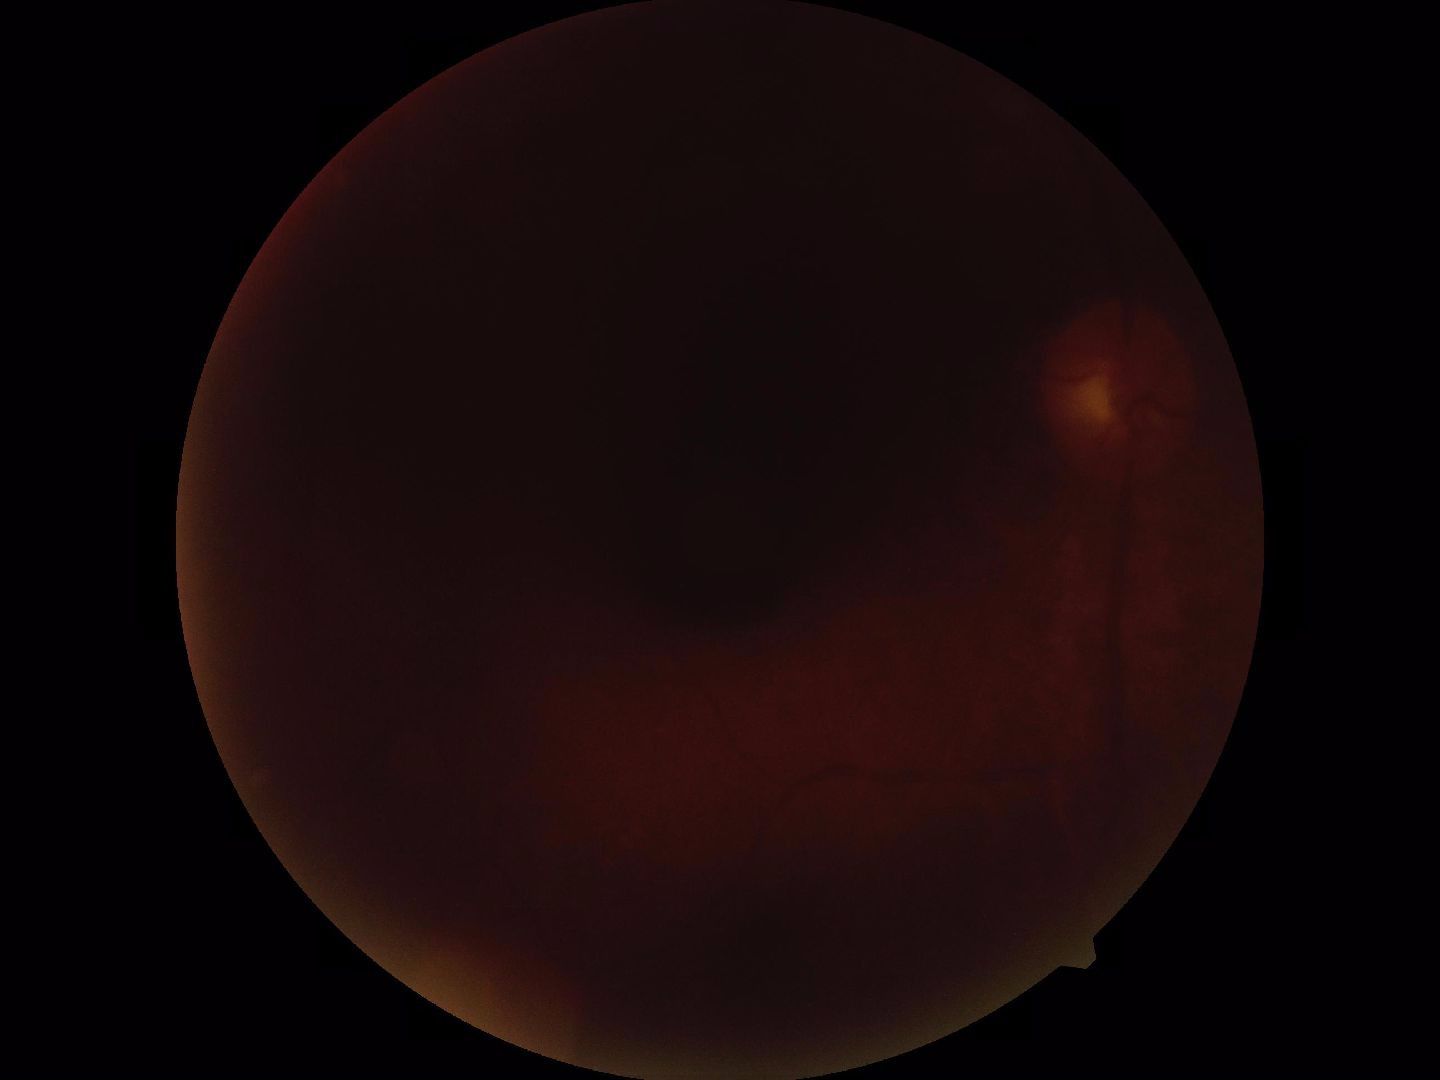

Blurred fundus image with substantial obscuration of retinal landmarks. No proliferative diabetic retinopathy identified.